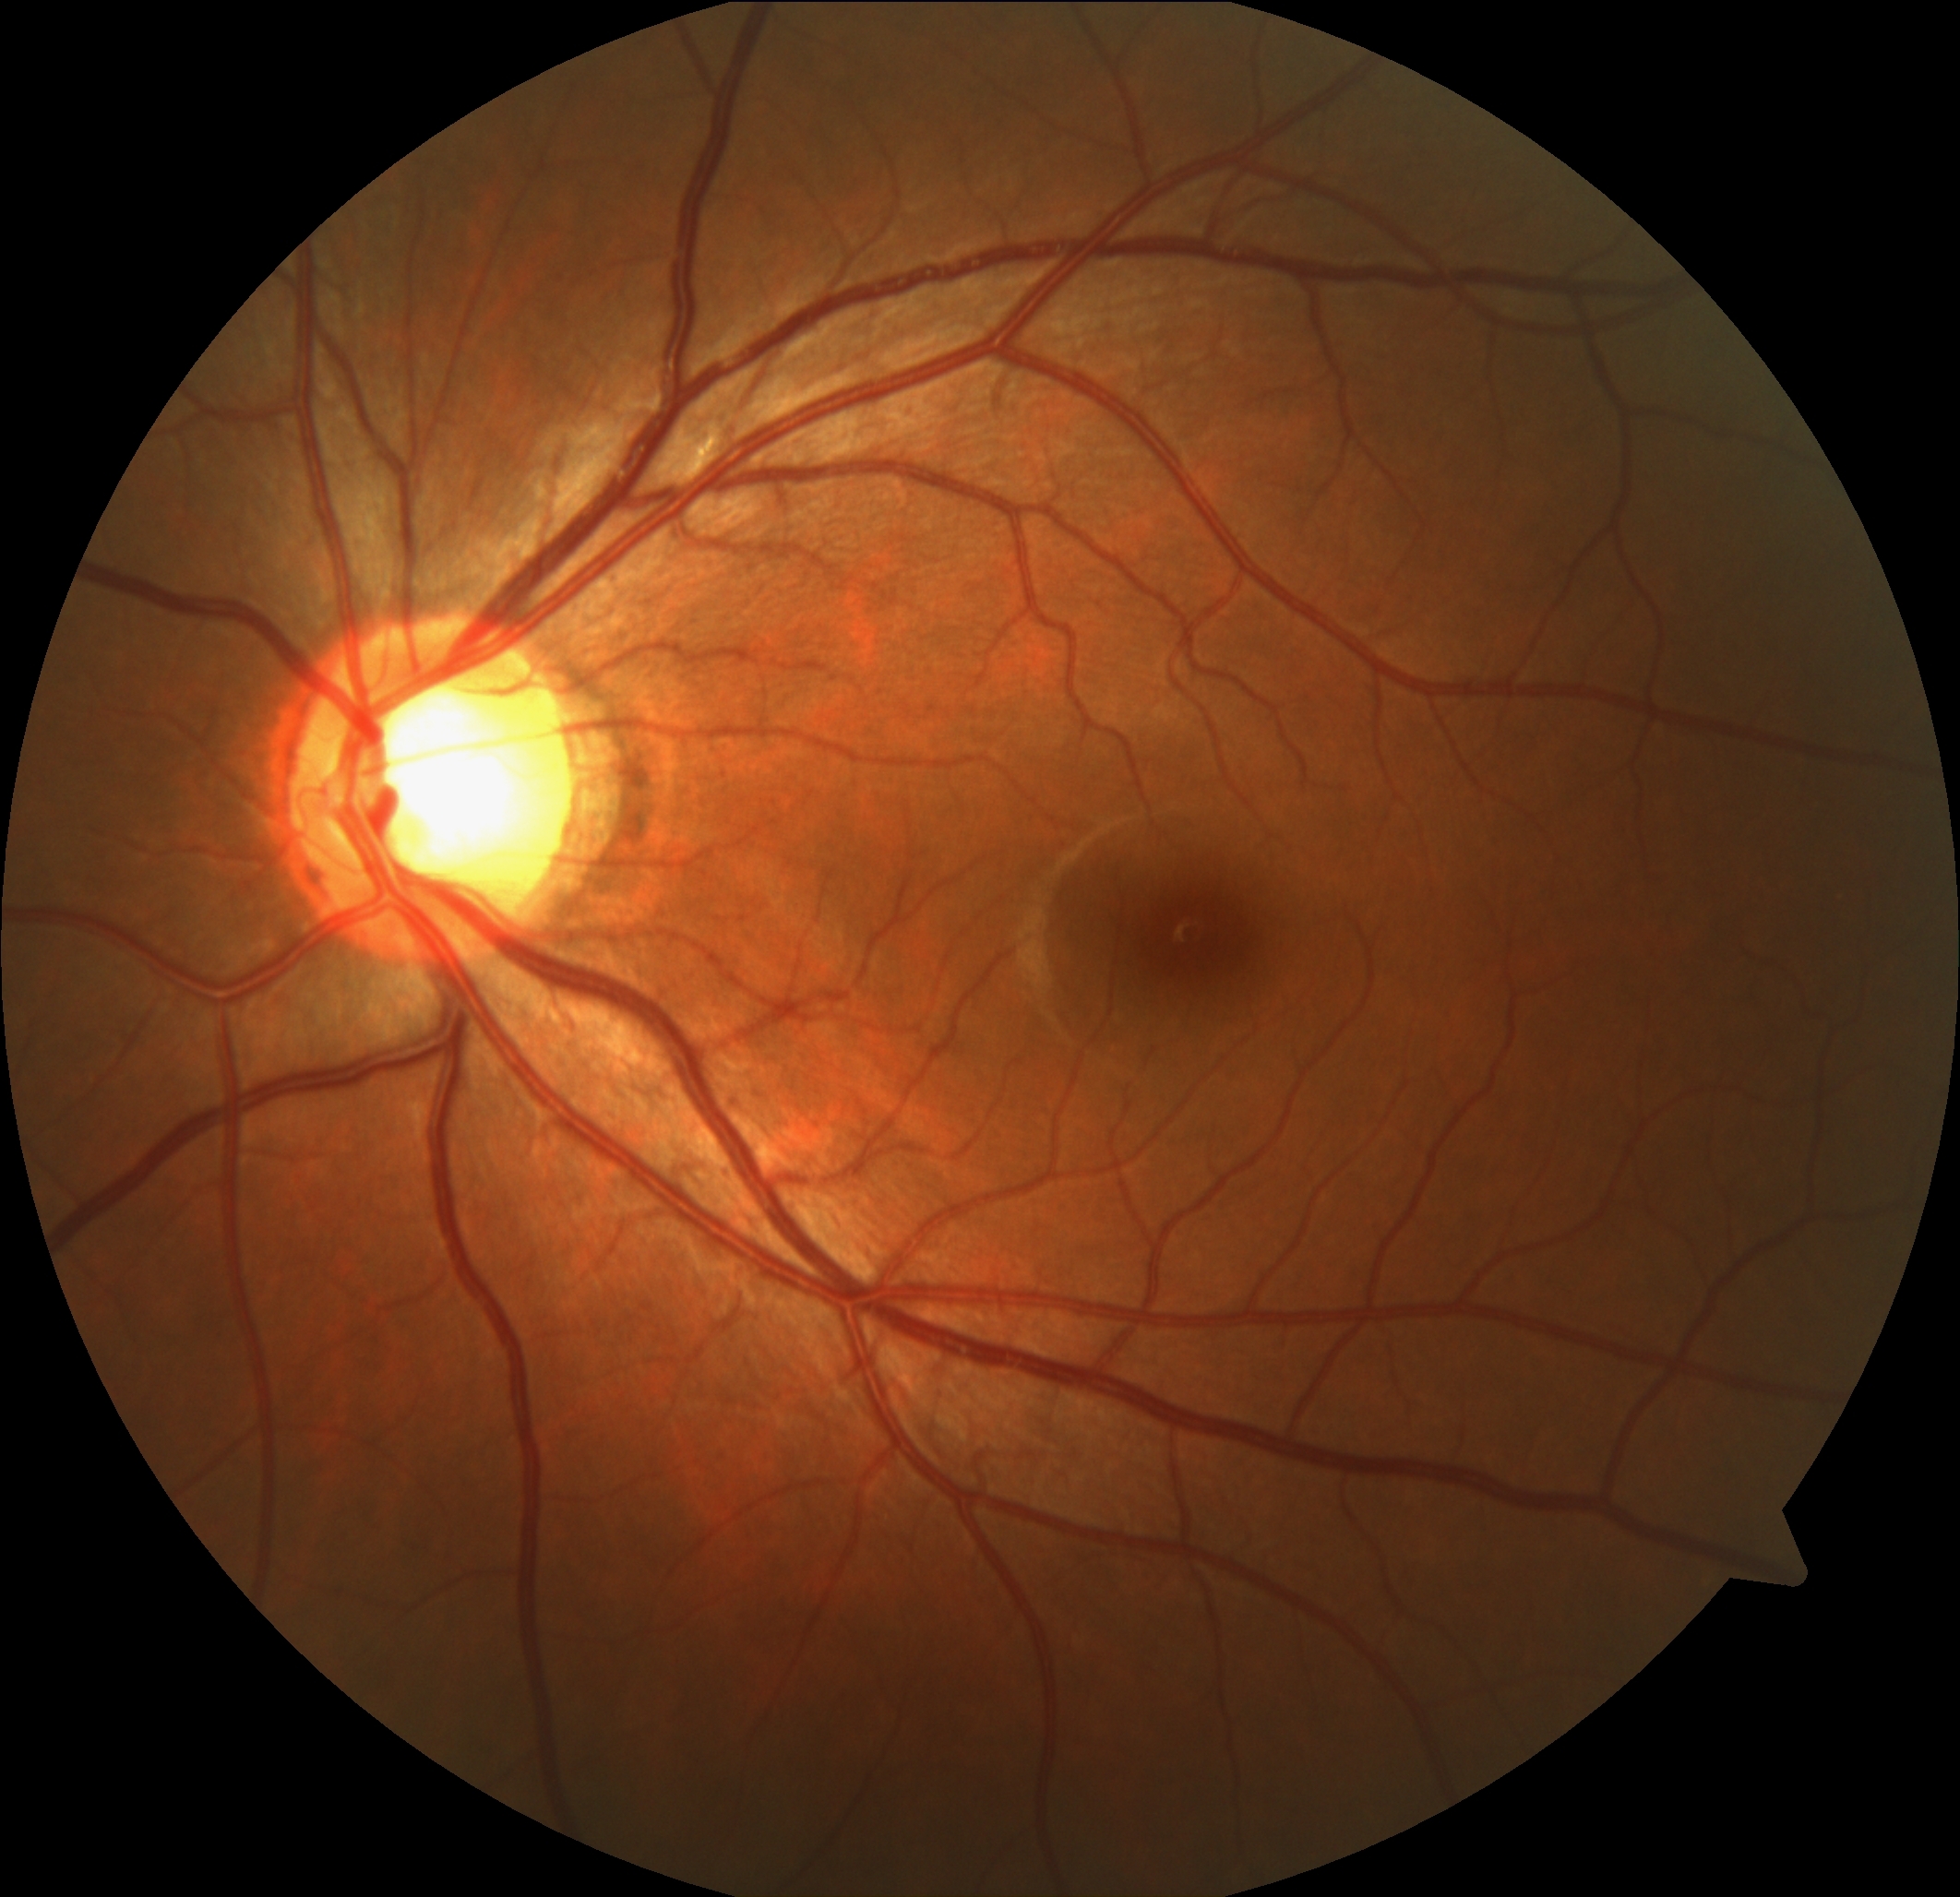 No DR findings. Retinopathy: 0/4.